Camera: Bosch handheld fundus camera
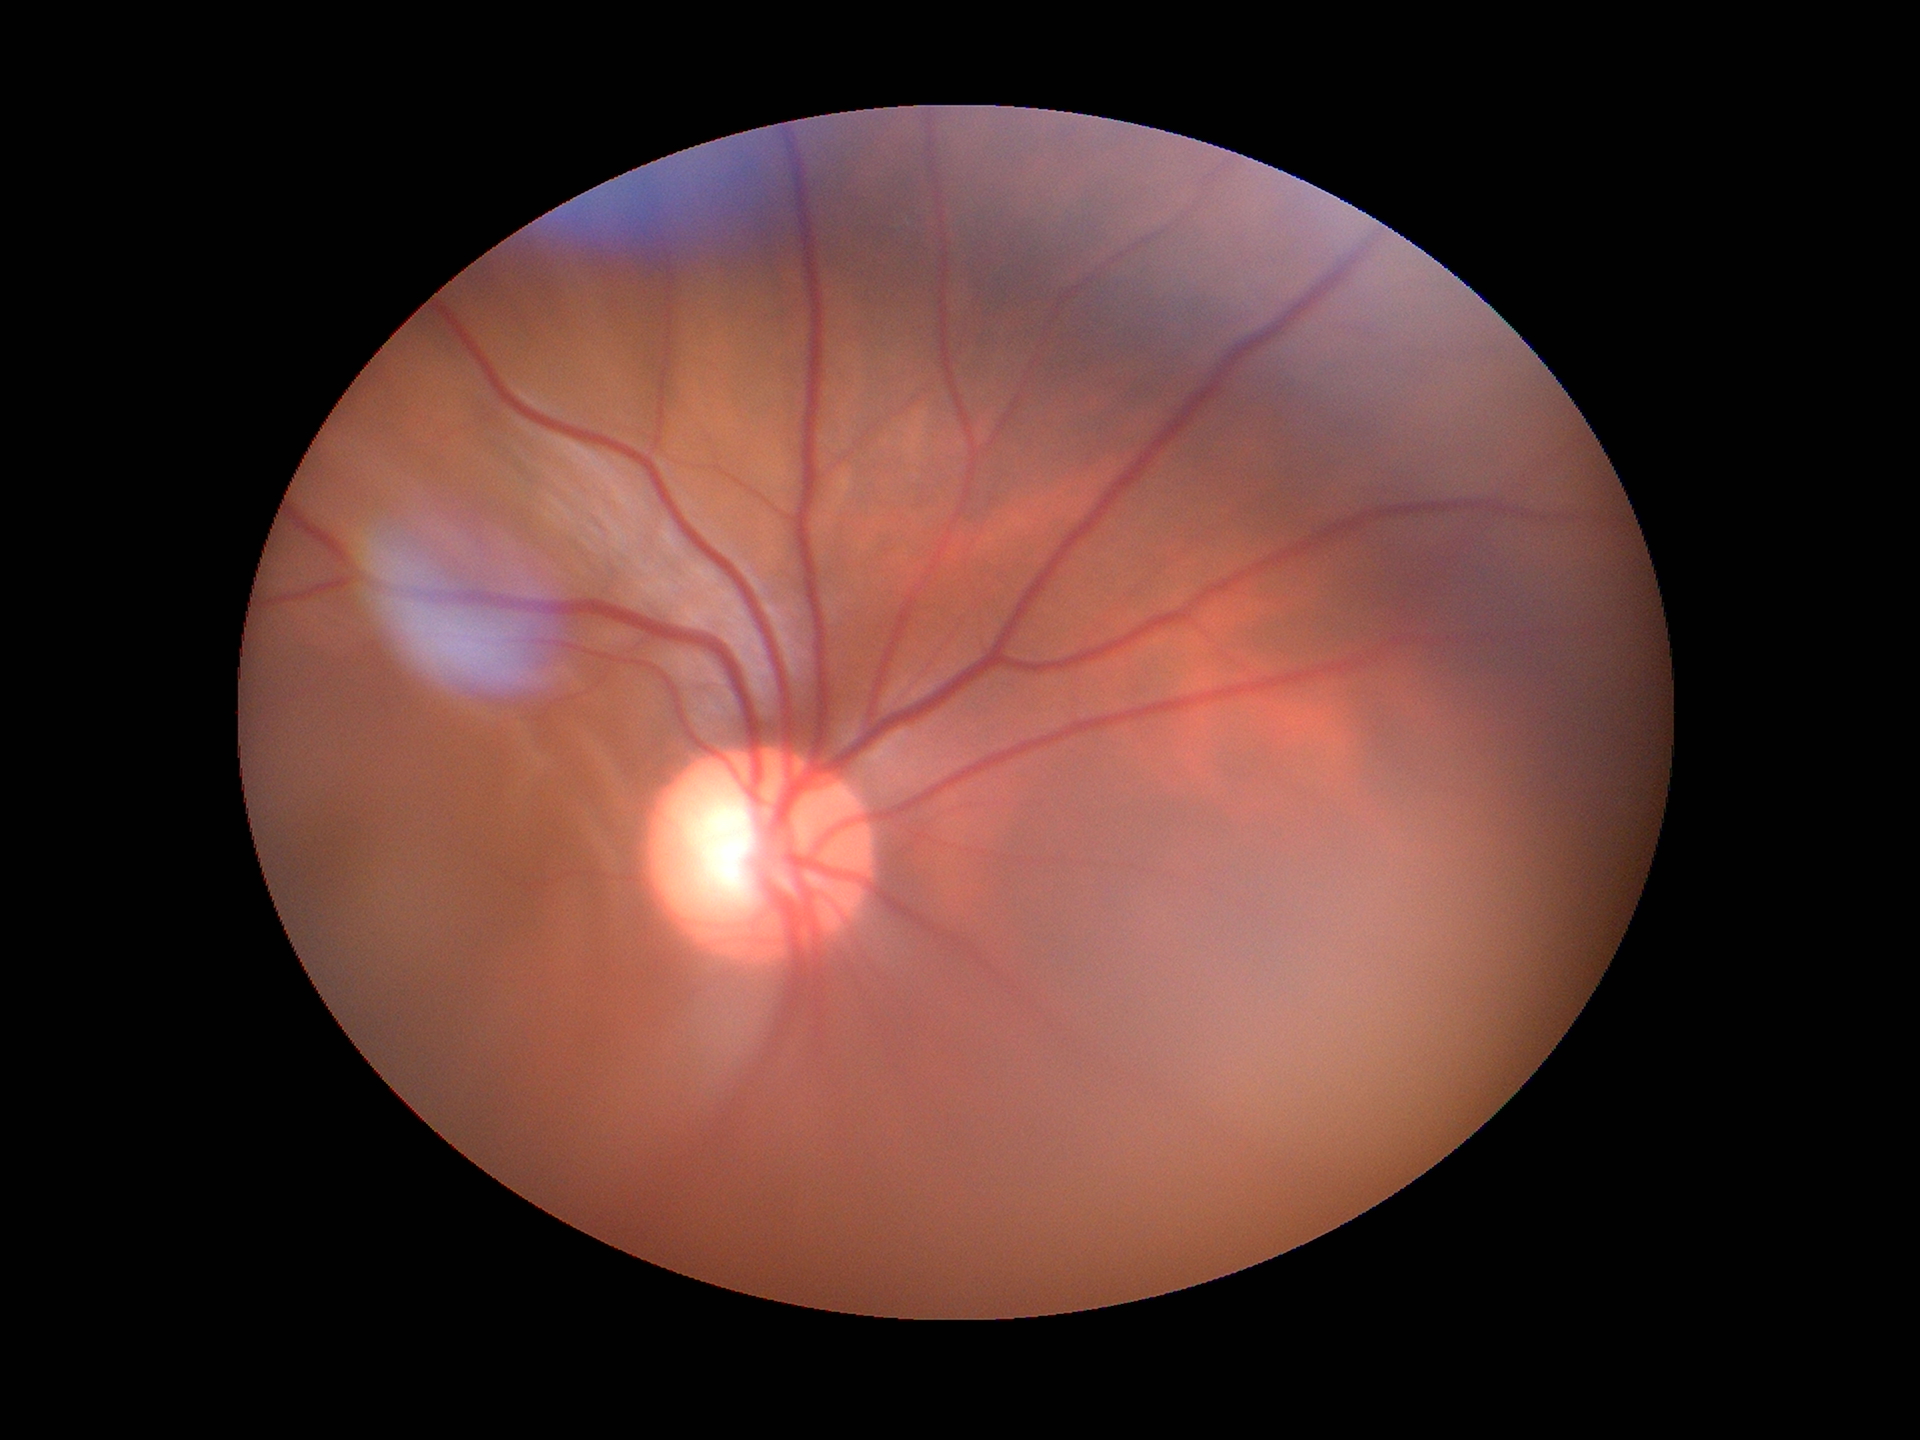

Glaucoma decision: not suspect
vertical cup-disc ratio: 0.63
area C/D ratio: 0.36